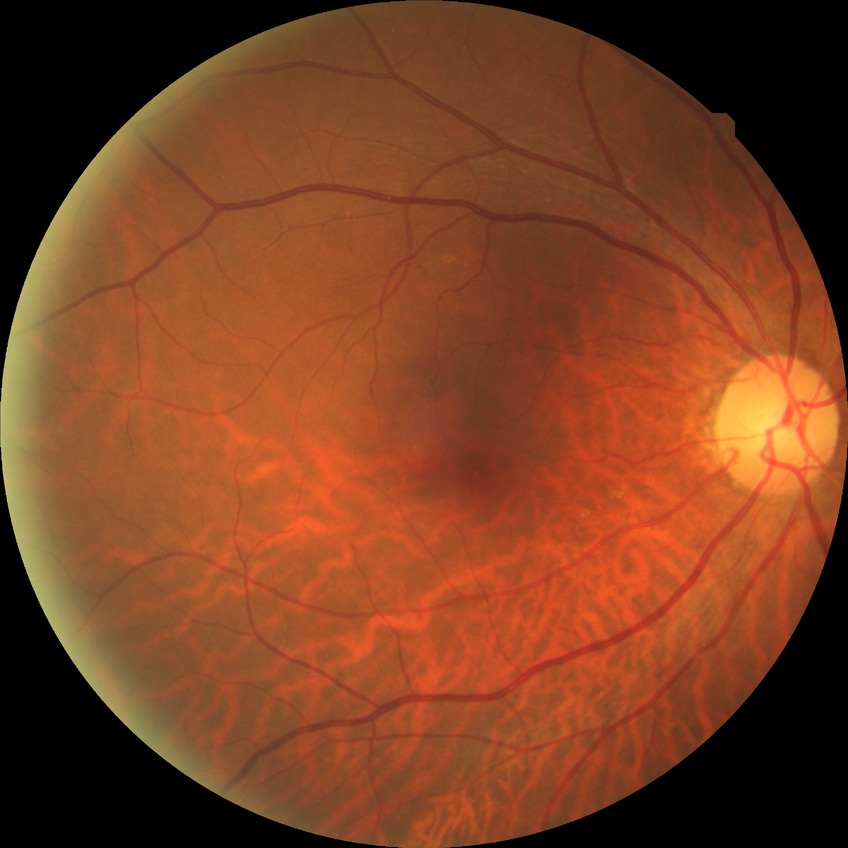
No diabetic retinal disease findings. Davis stage: NDR.